2352x1568, 45° FOV, CFP — 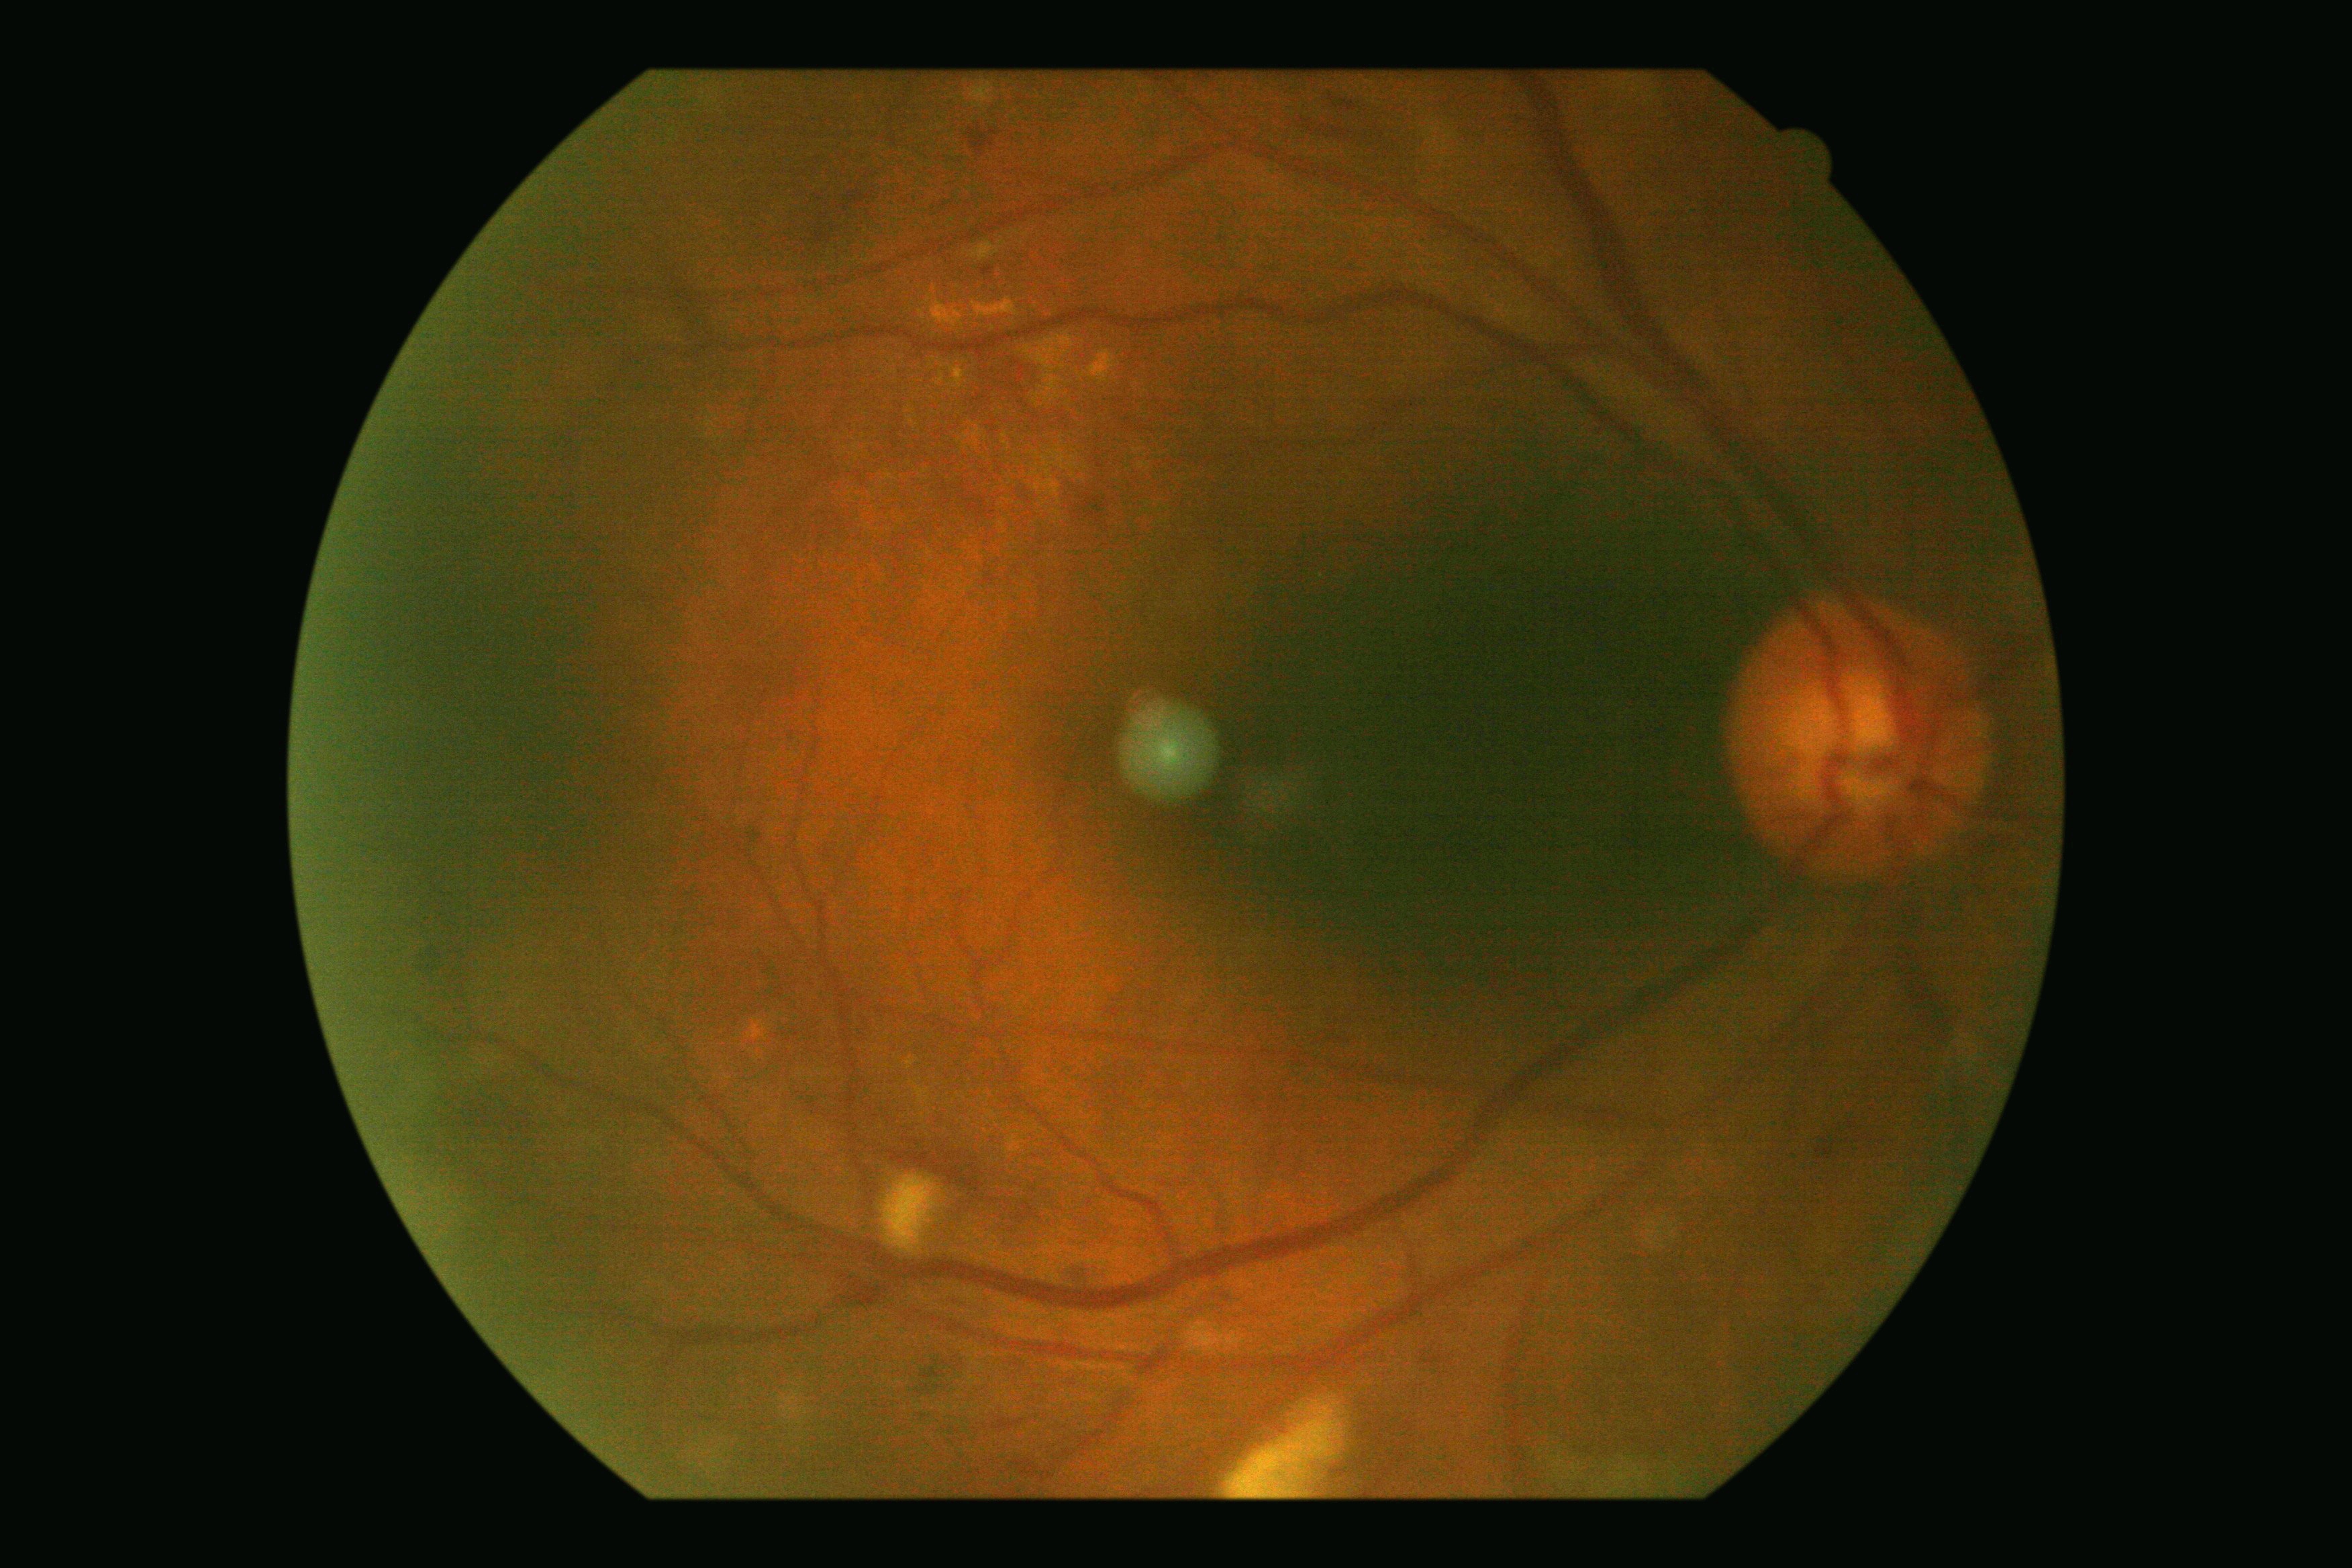 DR severity: 2.